Nonmydriatic fundus photograph. Color fundus photograph. Image size 848x848. FOV: 45 degrees. Diabetic retinopathy graded by the modified Davis classification.
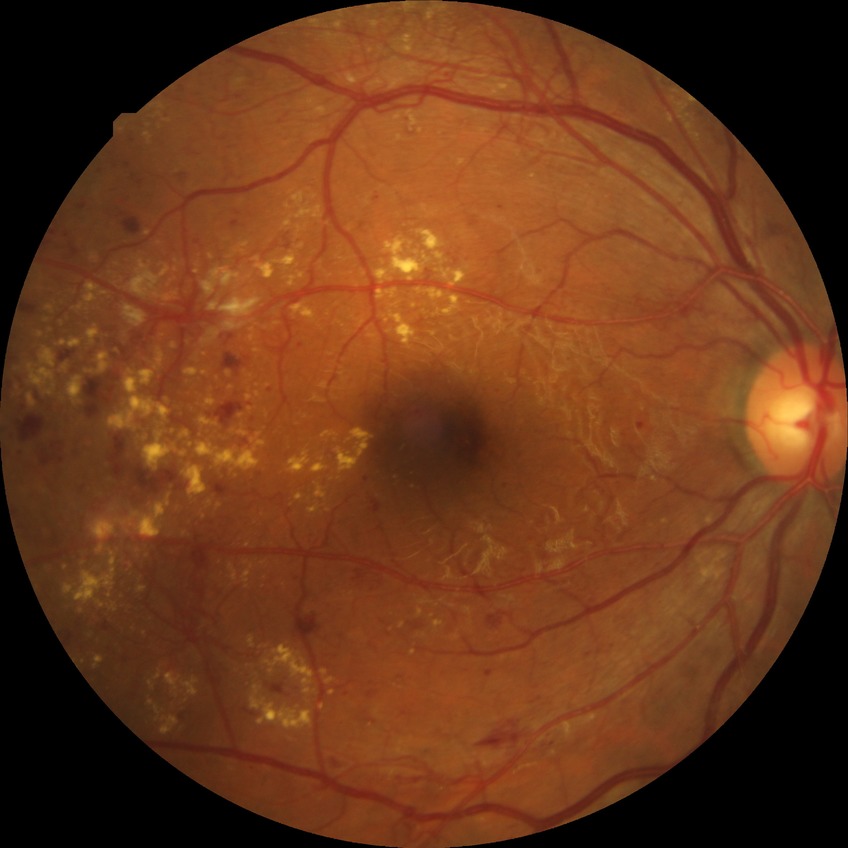   davis_grade: proliferative diabetic retinopathy (PDR)